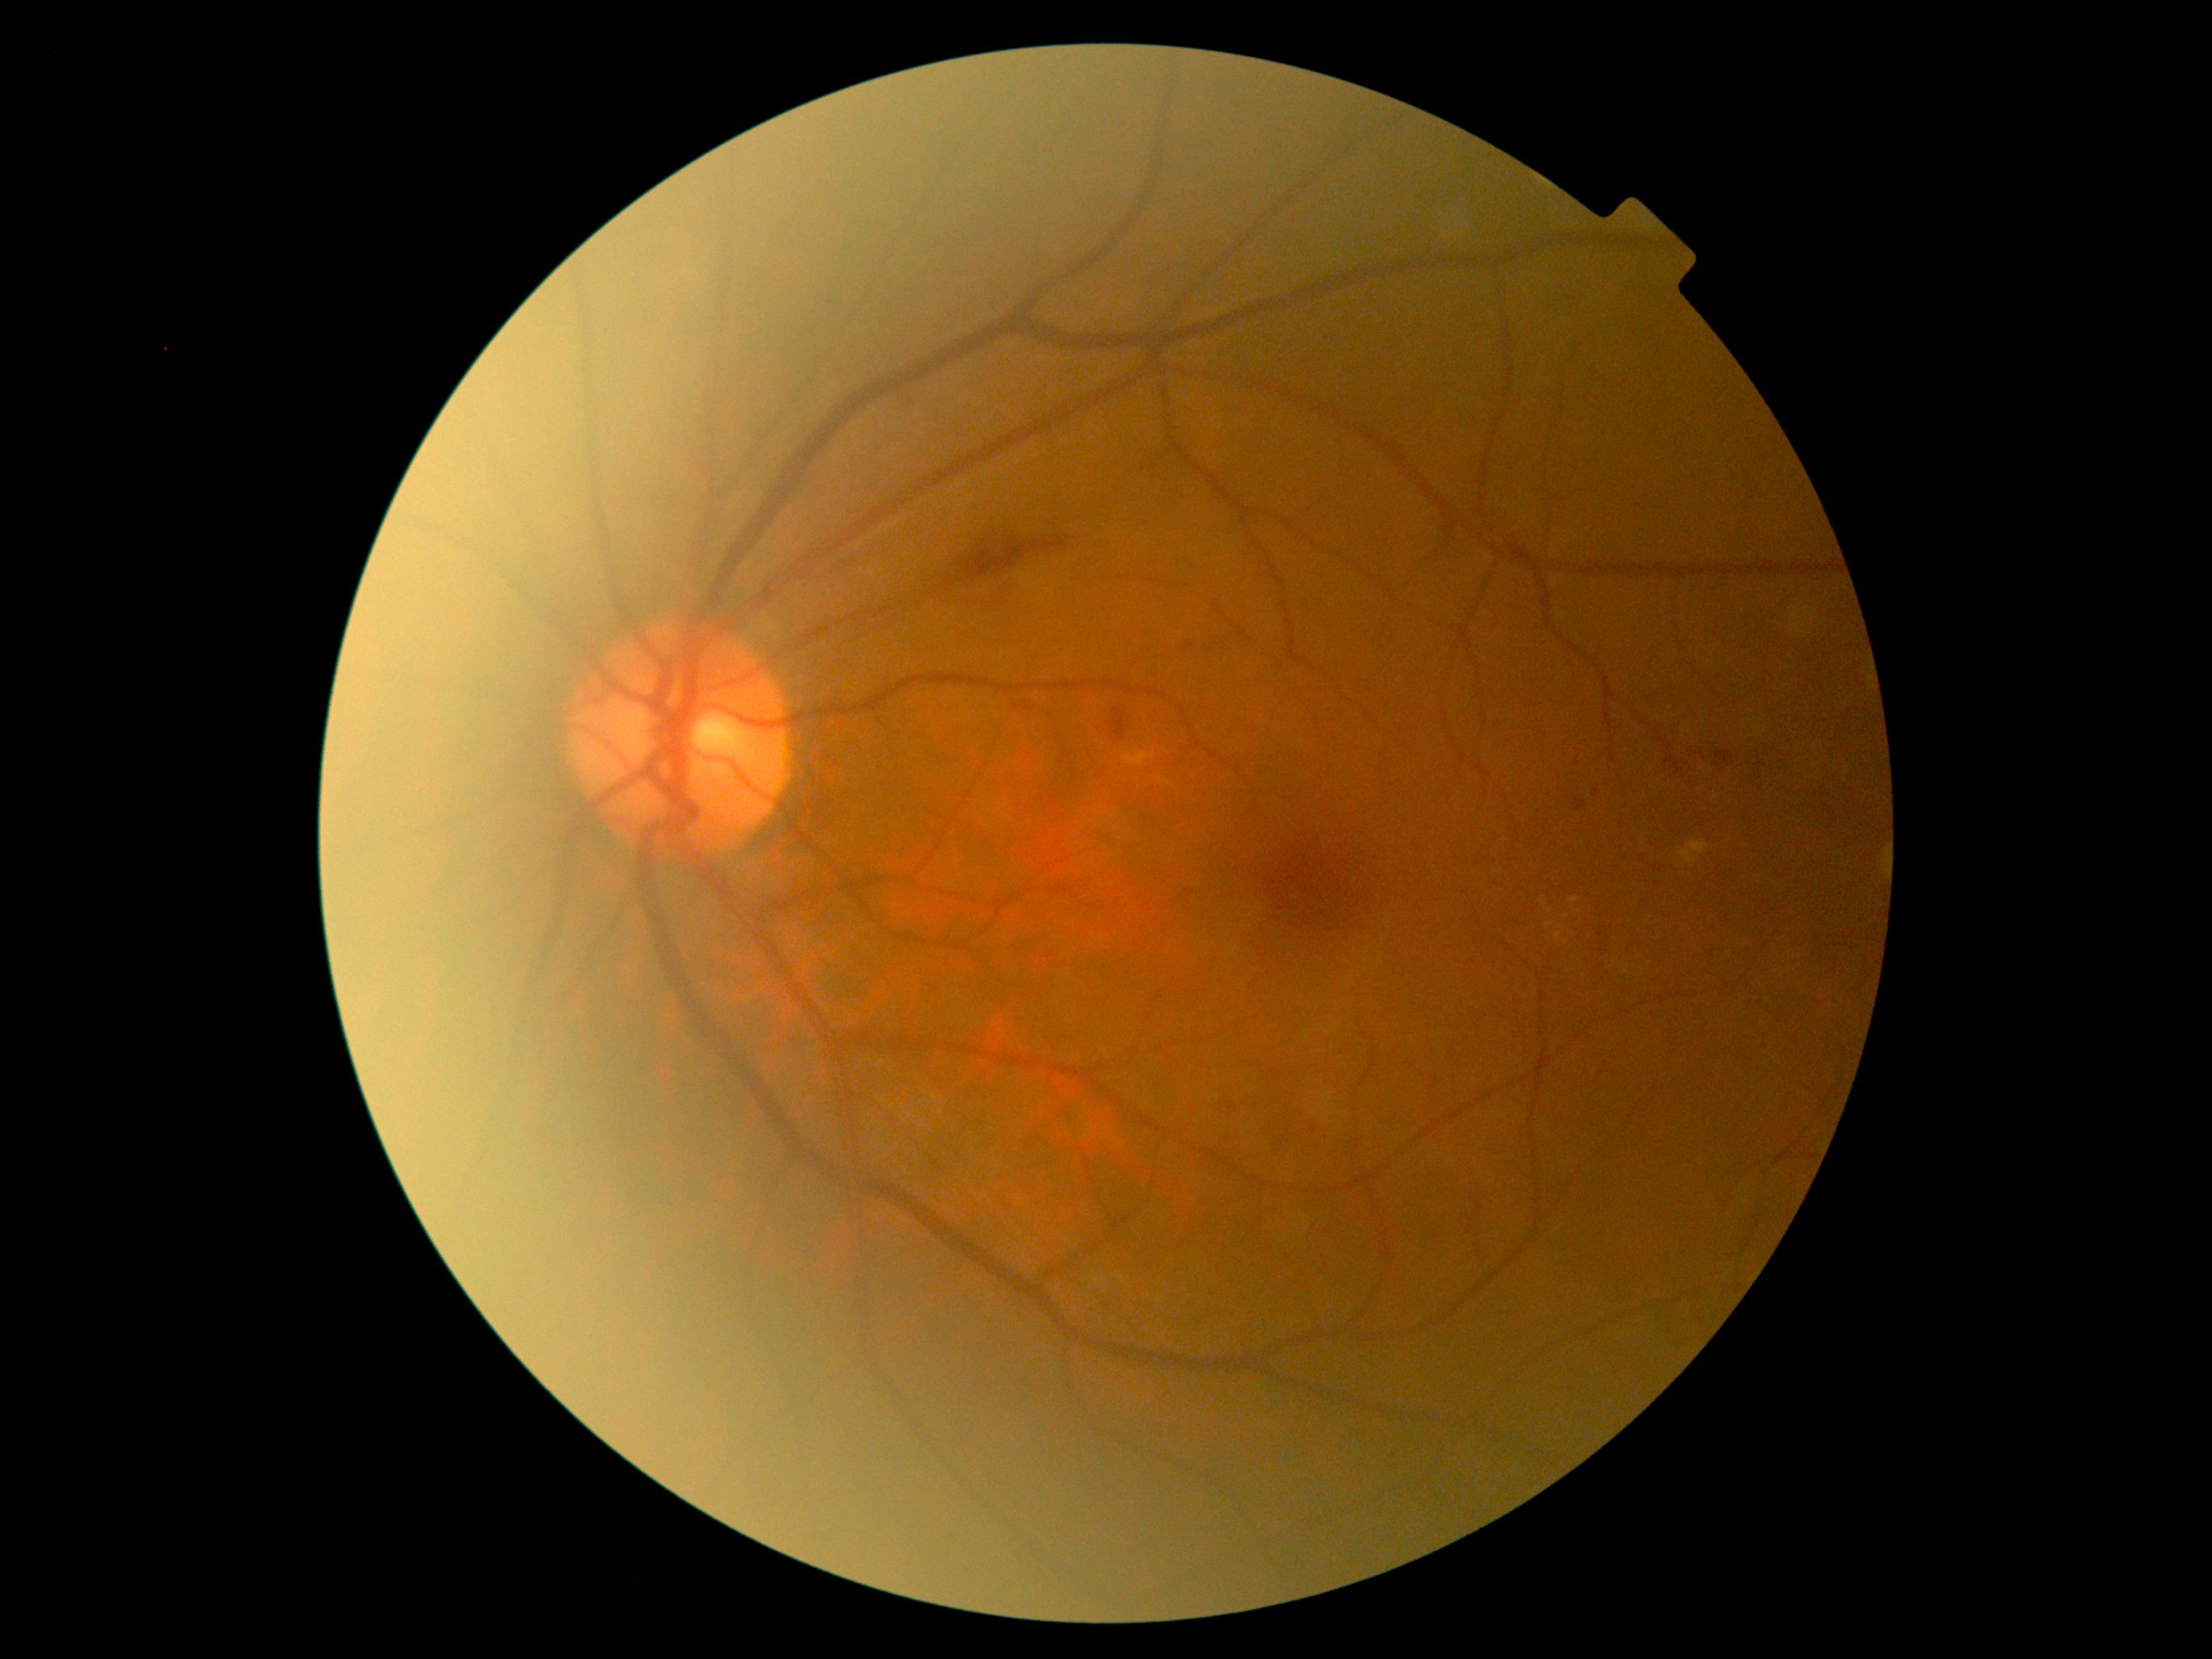

partial: true
dr_grade: 2
lesions:
  ma:
    - bbox=[1593, 790, 1600, 798]
  se: []
  he:
    - bbox=[1570, 800, 1588, 811]
    - bbox=[1443, 525, 1456, 556]
    - bbox=[1184, 642, 1195, 655]
    - bbox=[1275, 1138, 1283, 1147]
    - bbox=[945, 536, 1070, 586]
    - bbox=[1310, 1127, 1317, 1135]
    - bbox=[1108, 708, 1127, 742]
    - bbox=[1715, 747, 1734, 765]
  ex:
    - bbox=[1570, 897, 1580, 905]
    - bbox=[1713, 792, 1719, 800]
    - bbox=[1679, 842, 1708, 864]
    - bbox=[1126, 753, 1153, 768]
  ex_small_centers:
    - 1559:936
    - 1565:918
    - 1578:912
    - 1548:911